Retinal fundus photograph; dilated-pupil acquisition; FOV: 50 degrees; 2228x1652; acquired with a Topcon TRC-50DX:
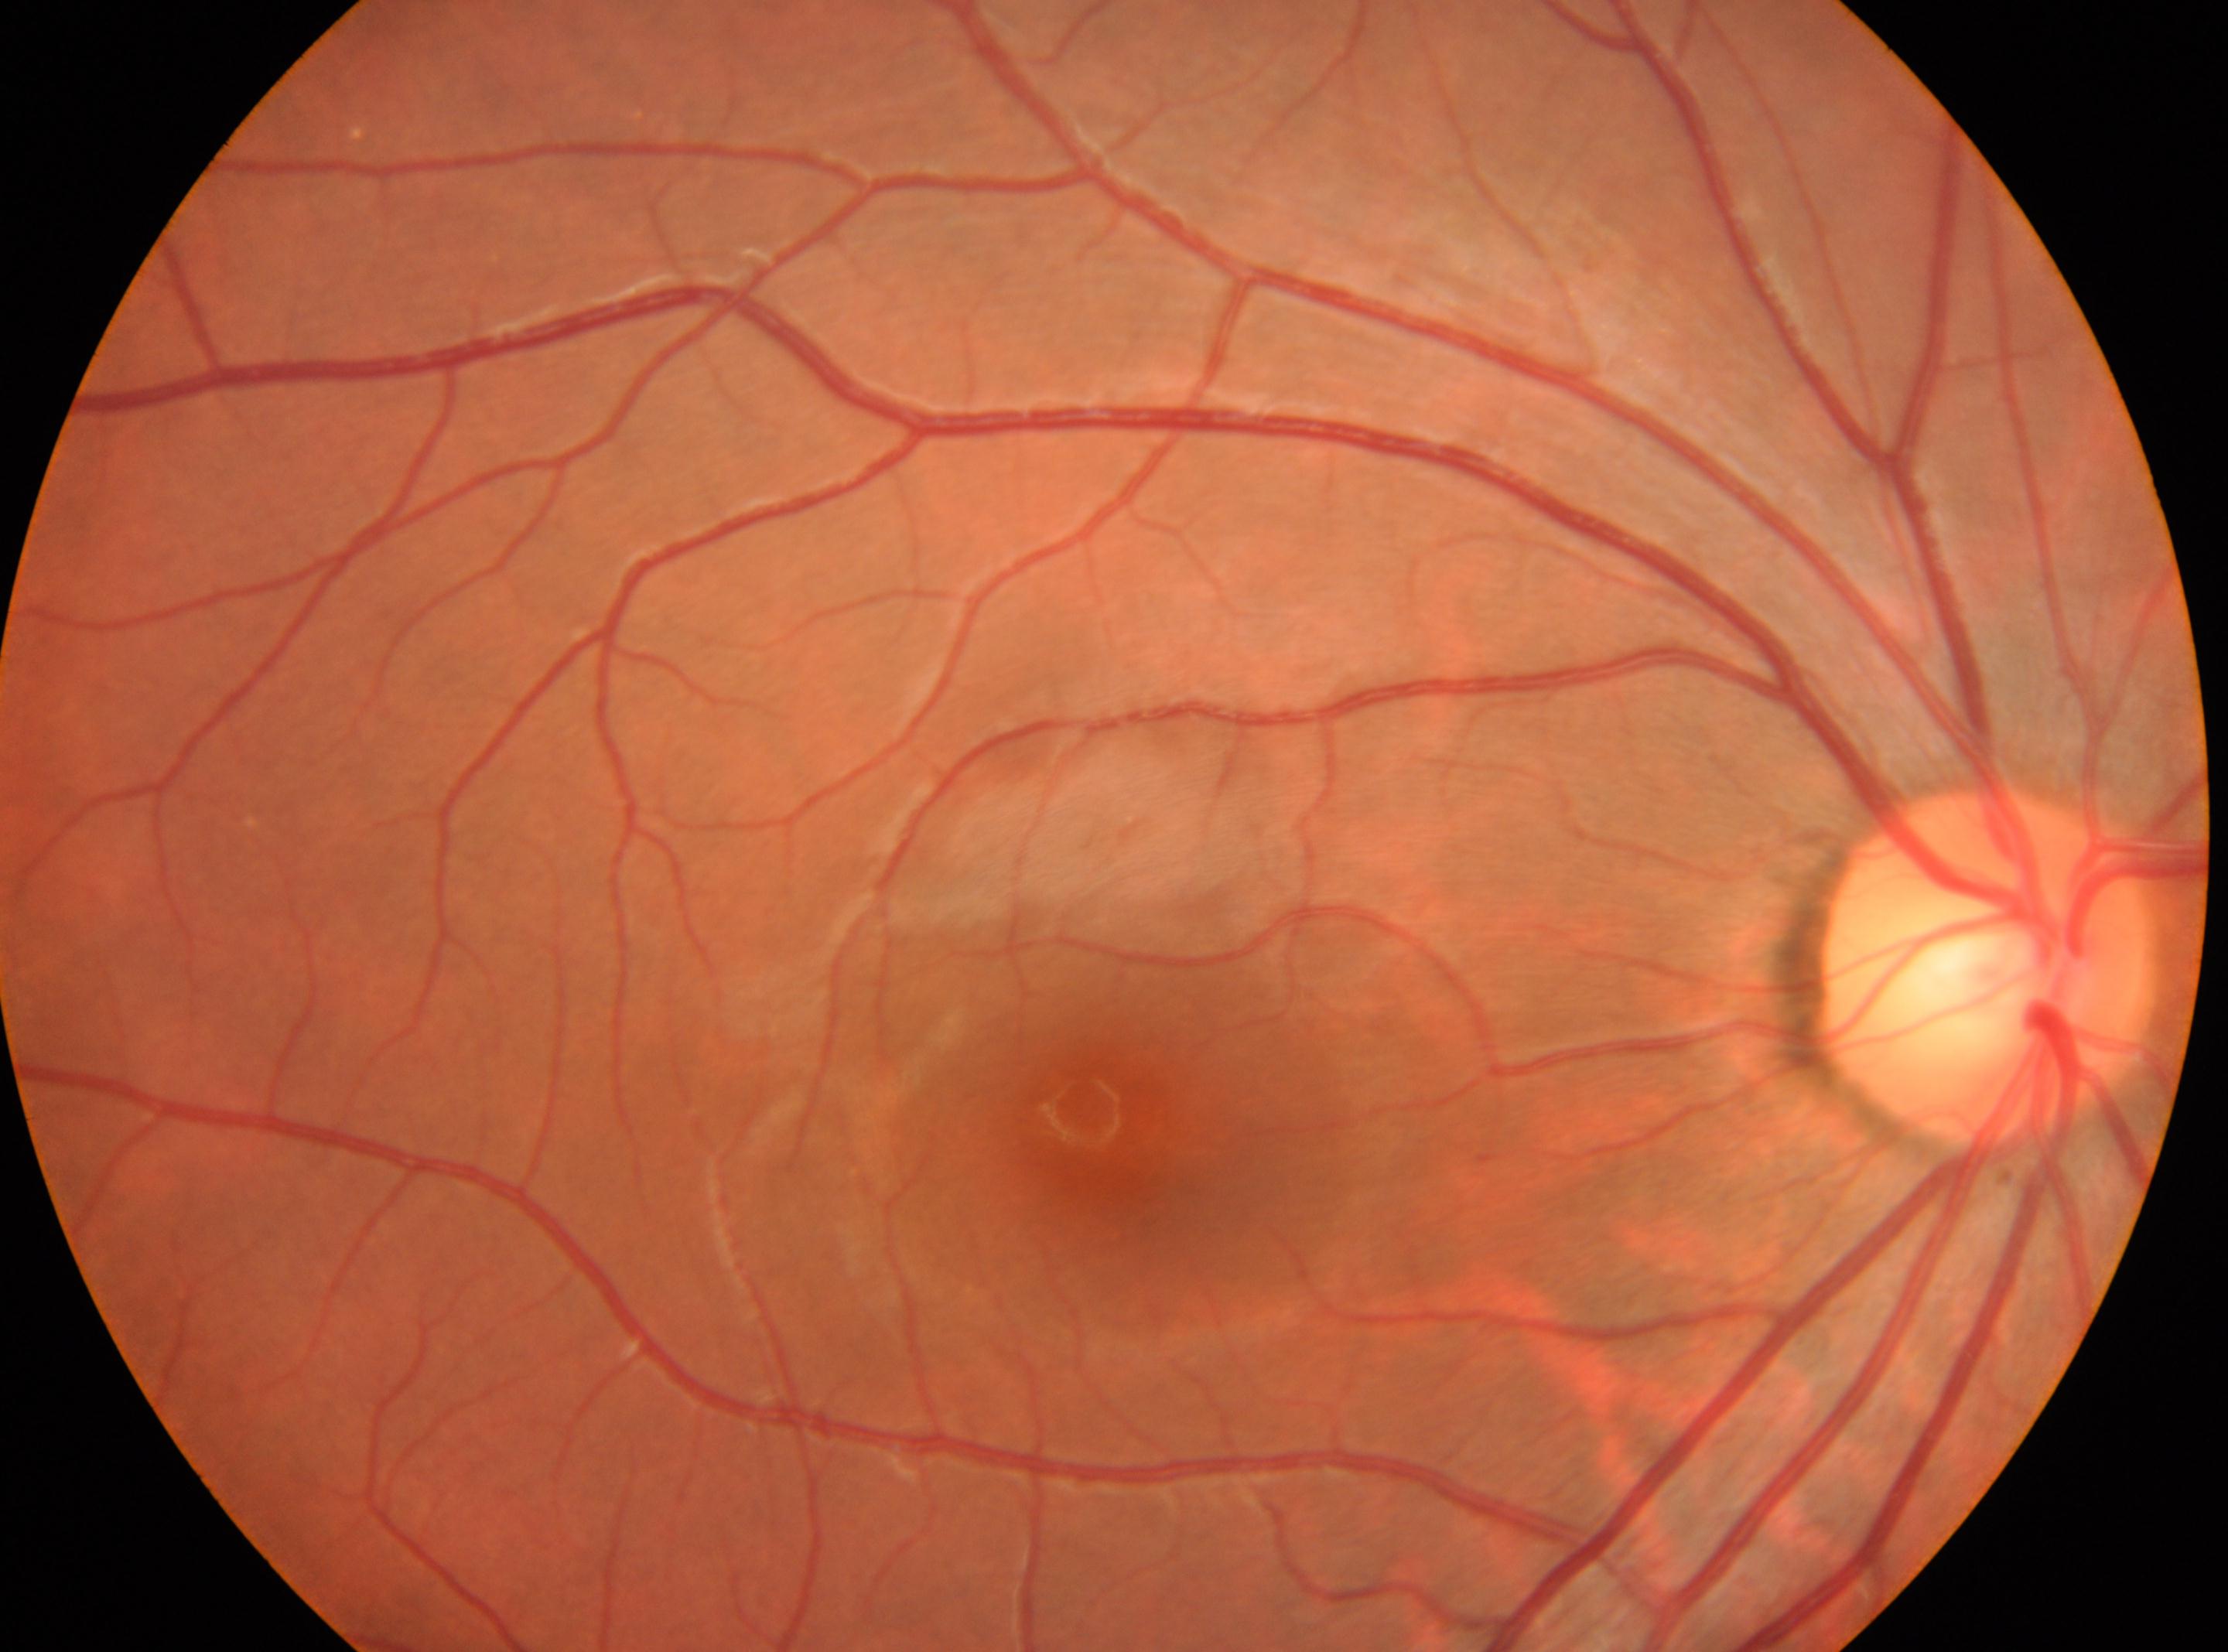

Optic nerve head: (x: 1984, y: 962).
DR stage: 0.
Imaged eye: OD.
No diabetic retinal disease findings.
Fovea centralis located at (x: 1128, y: 1128).